Color fundus image — 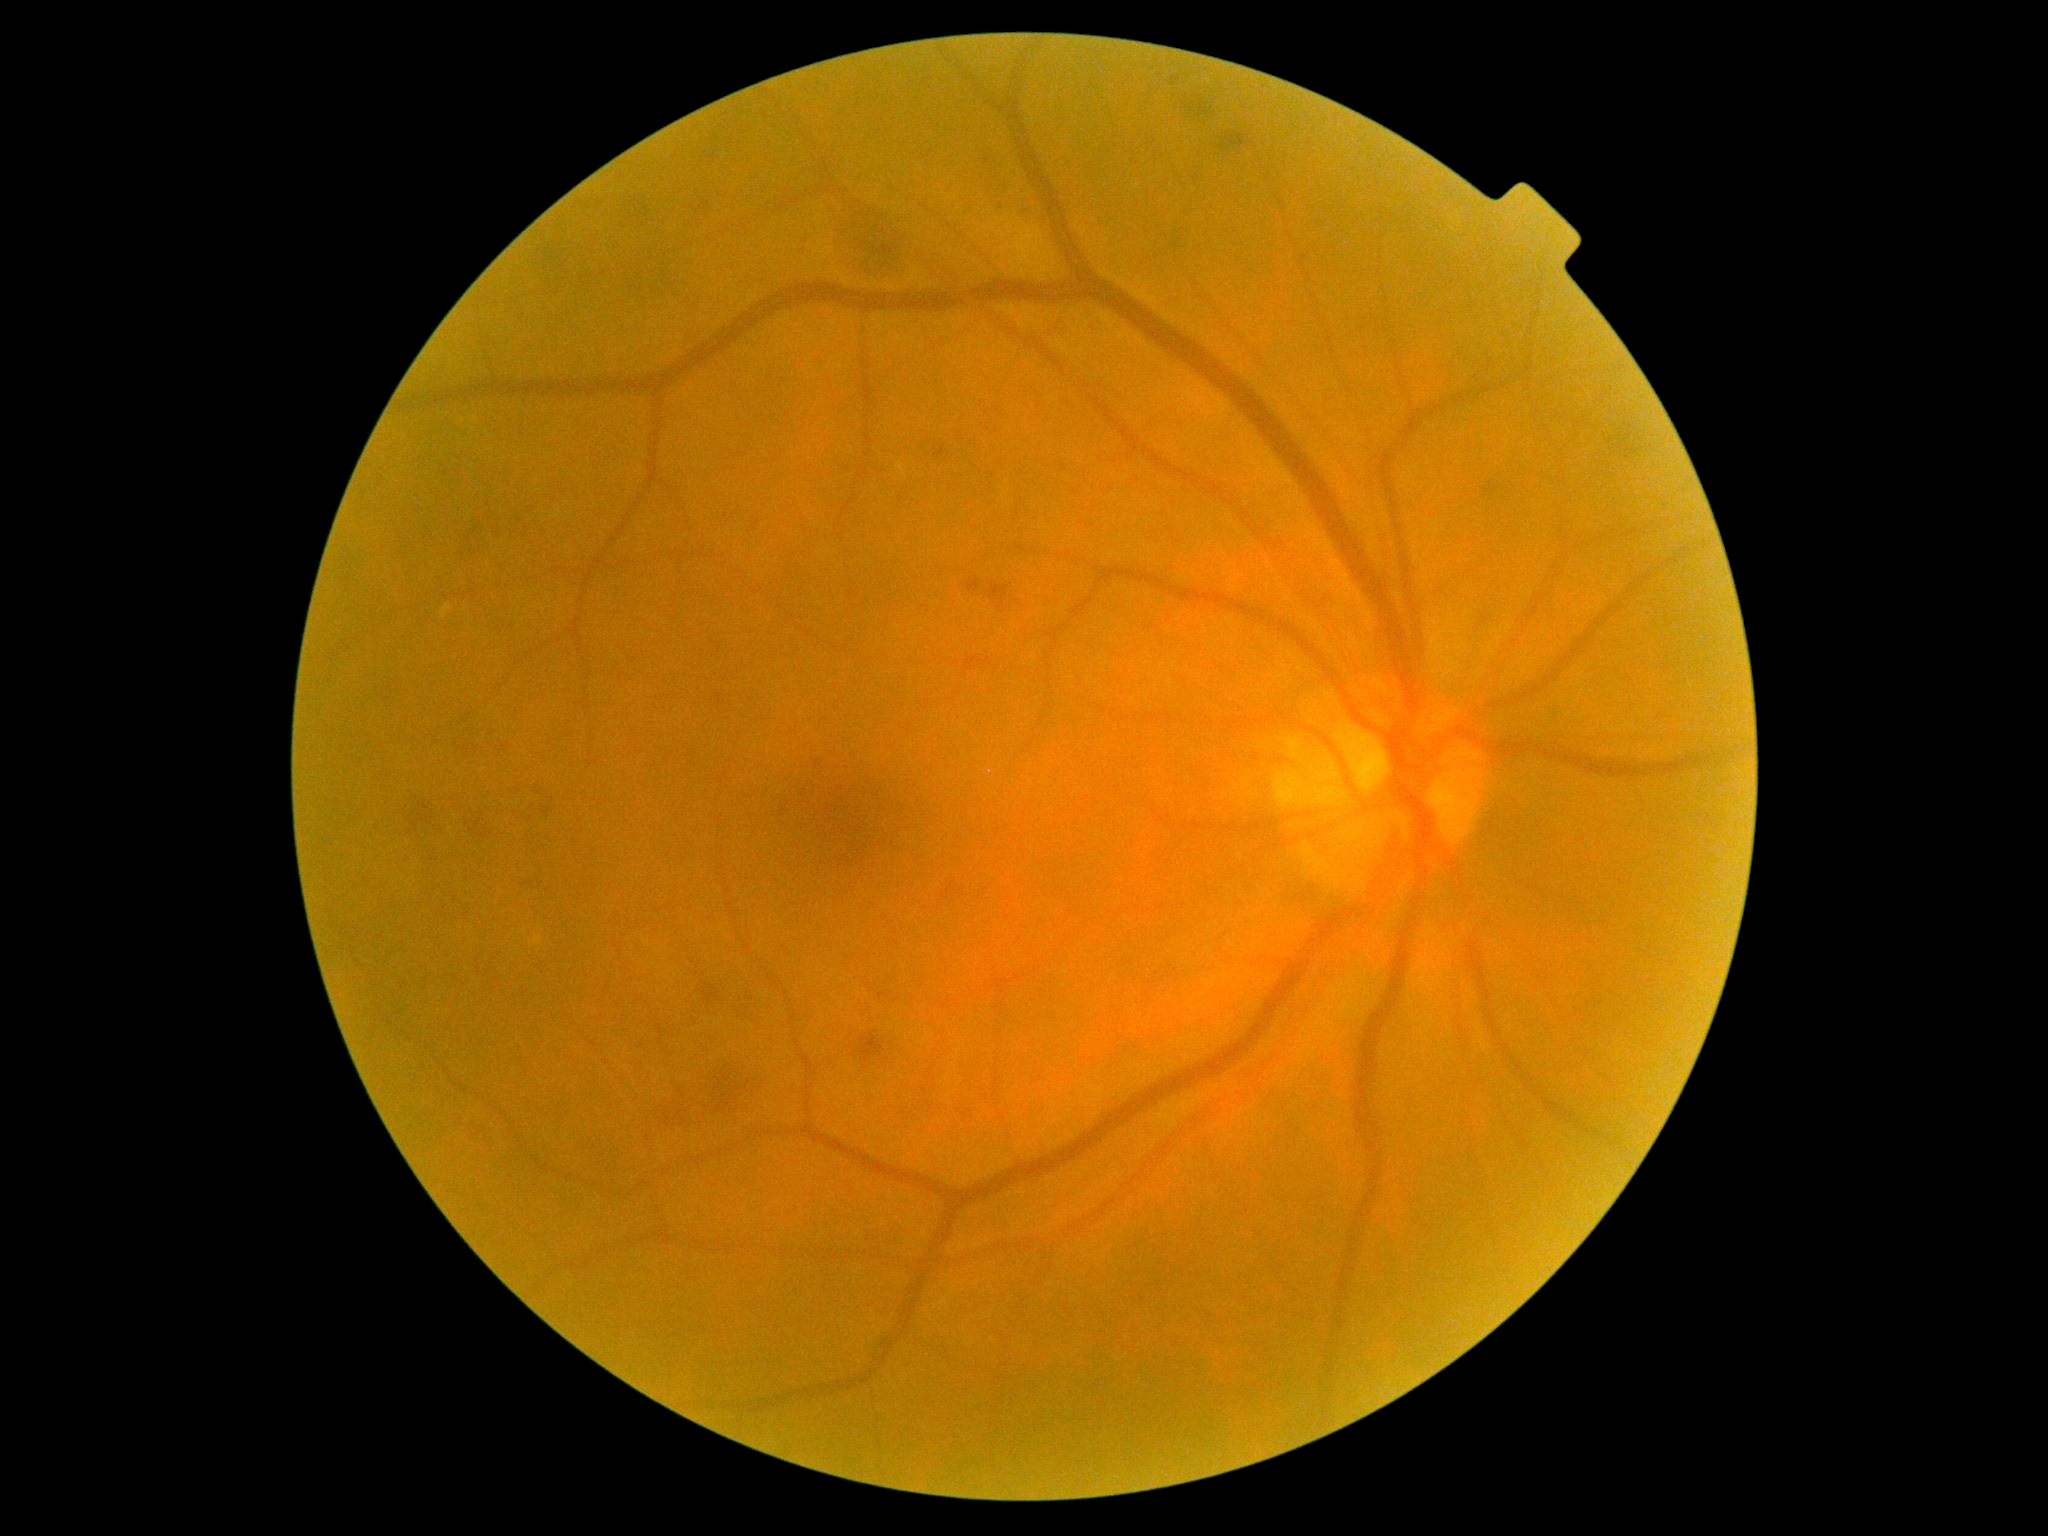
Annotations:
- diabetic retinopathy (DR): grade 2 (moderate NPDR) — more than just microaneurysms but less than severe NPDR